Image size 848x848:
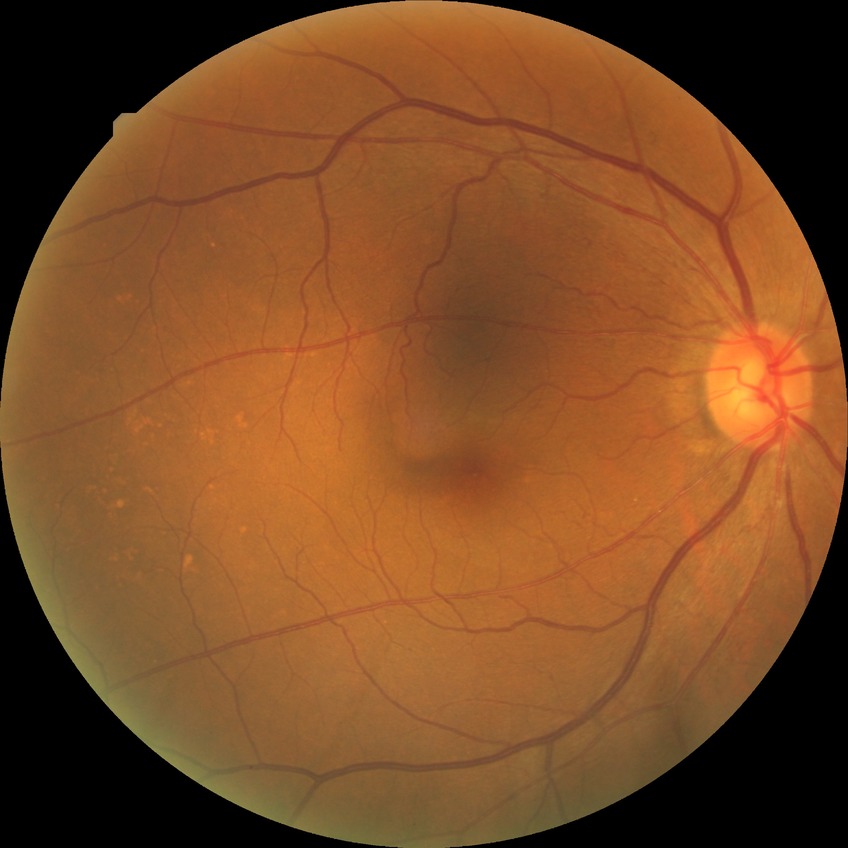

No DR findings. Modified Davis grade: NDR.